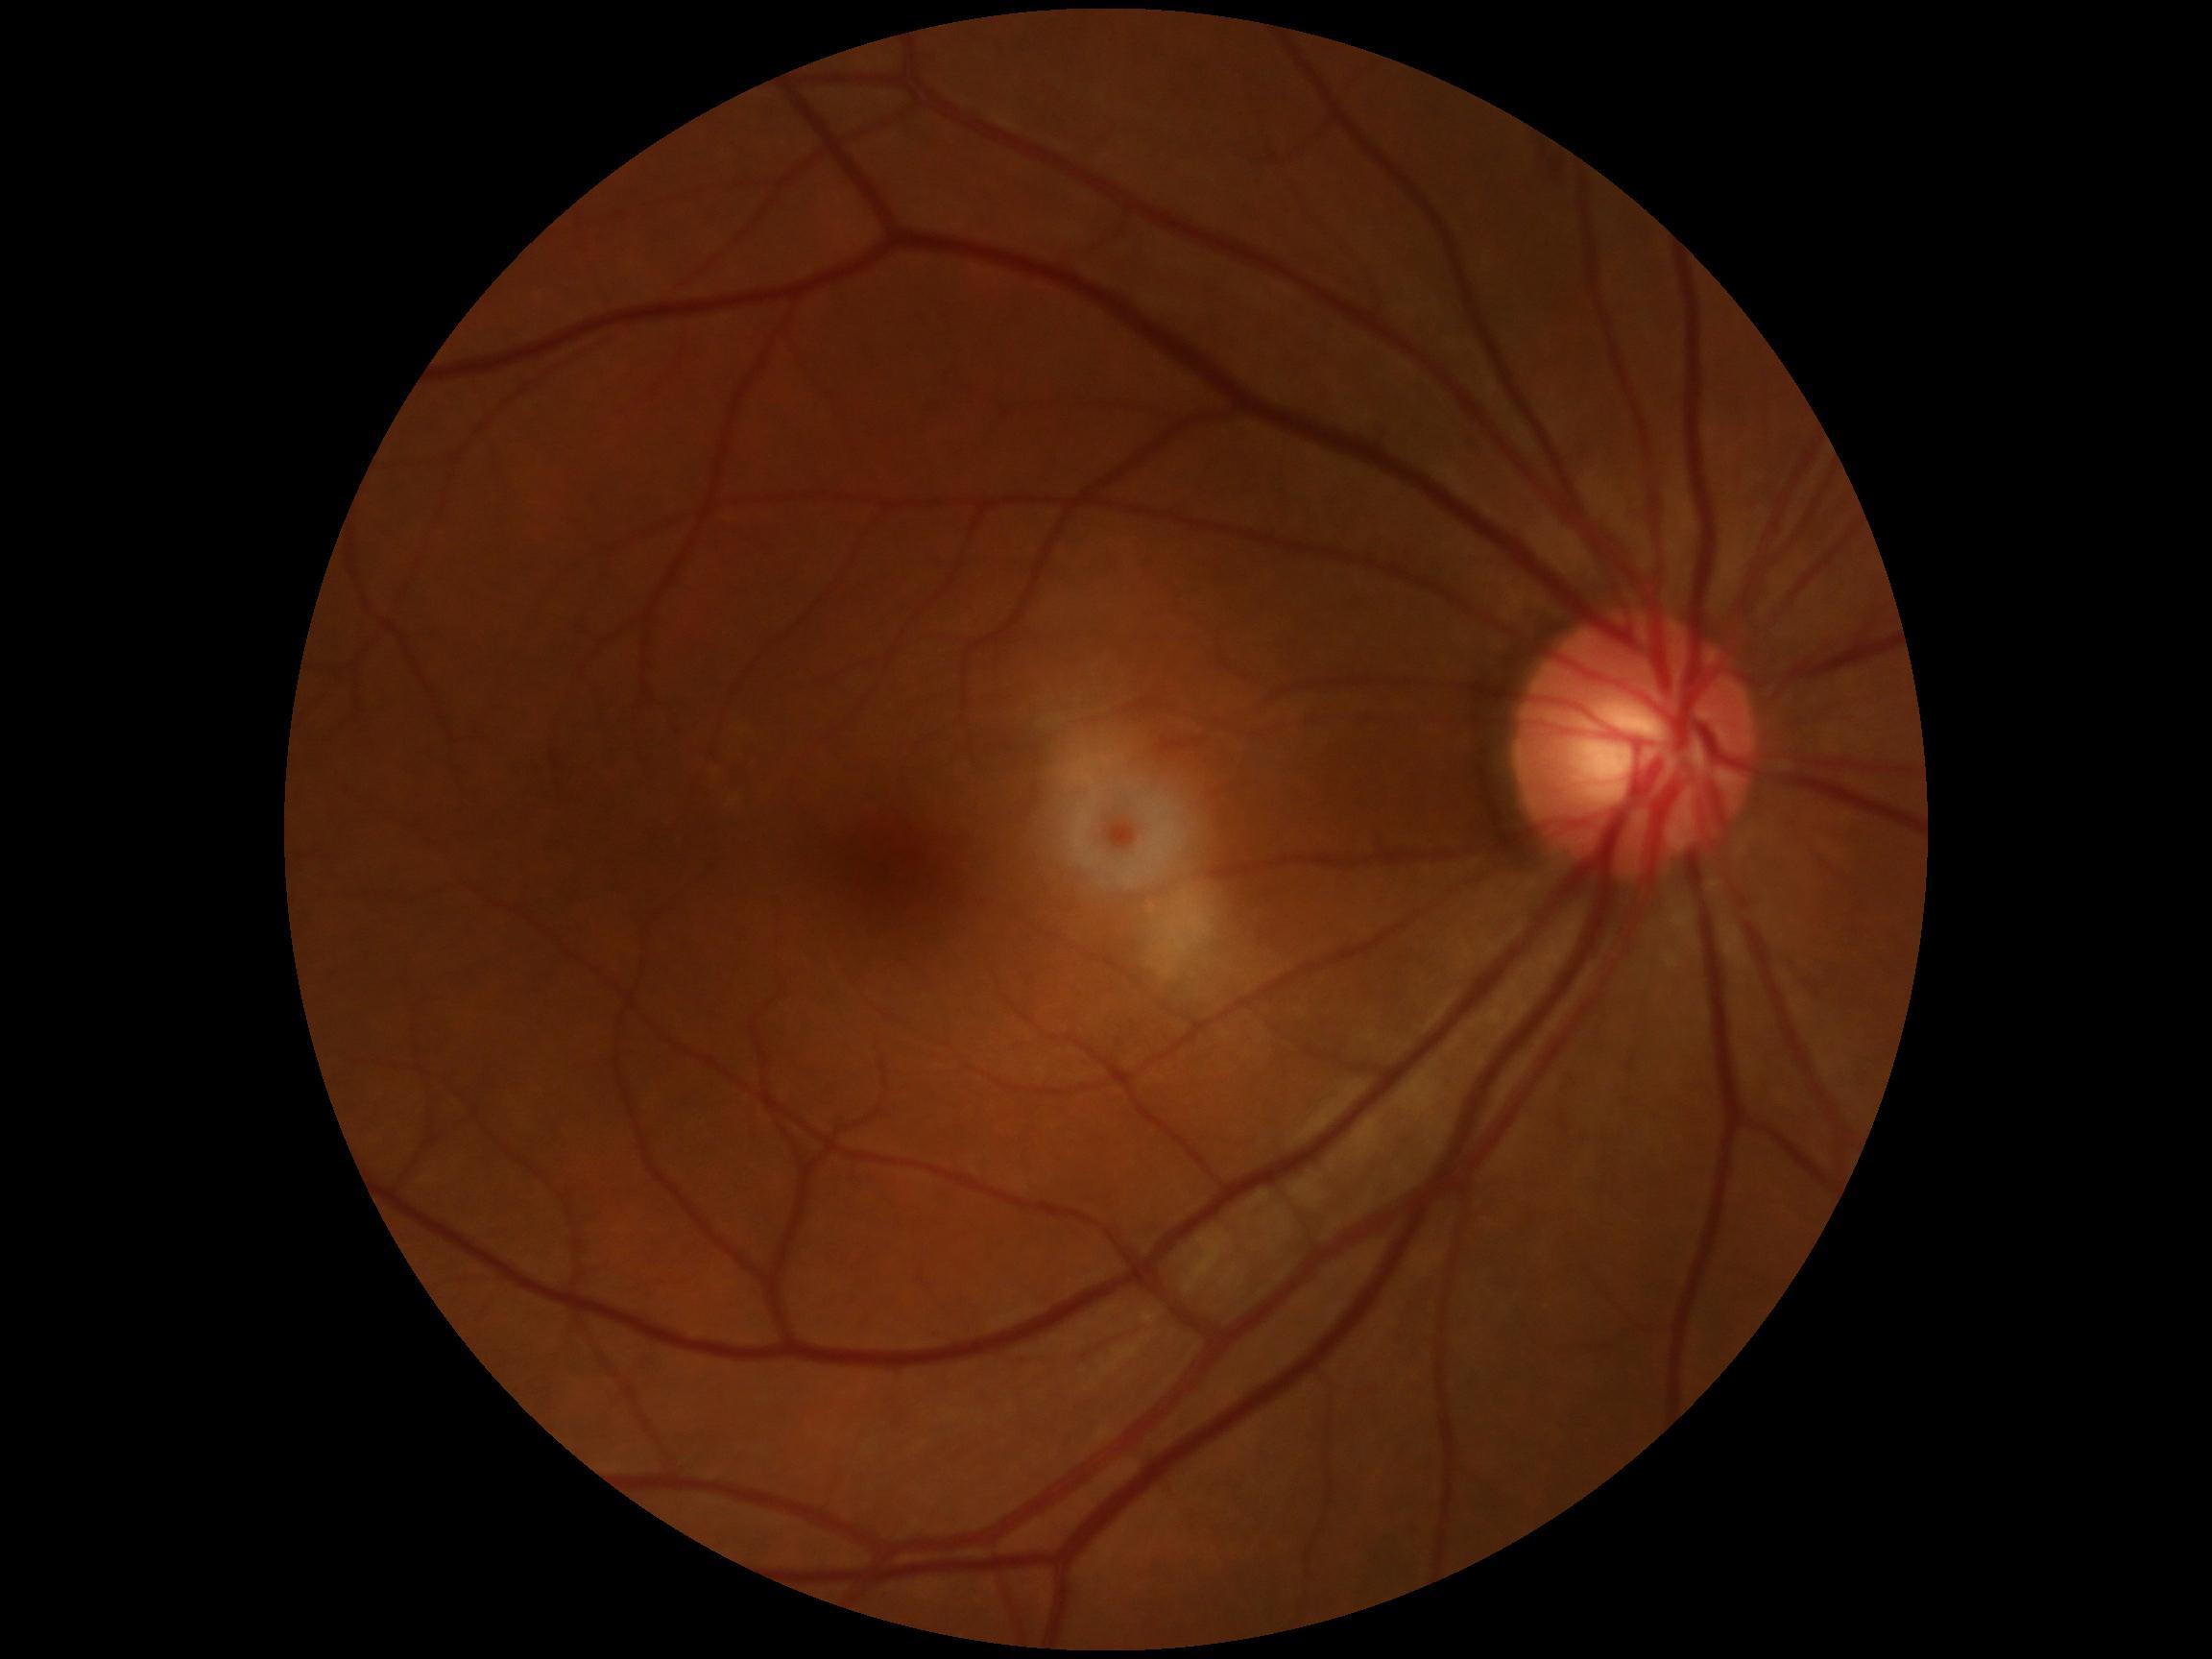

No diabetic retinal disease findings. DR stage is no apparent retinopathy (grade 0).